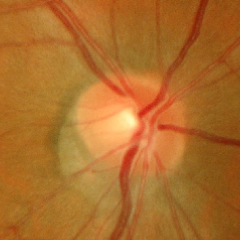 Impression = no evidence of glaucoma.